50° field of view
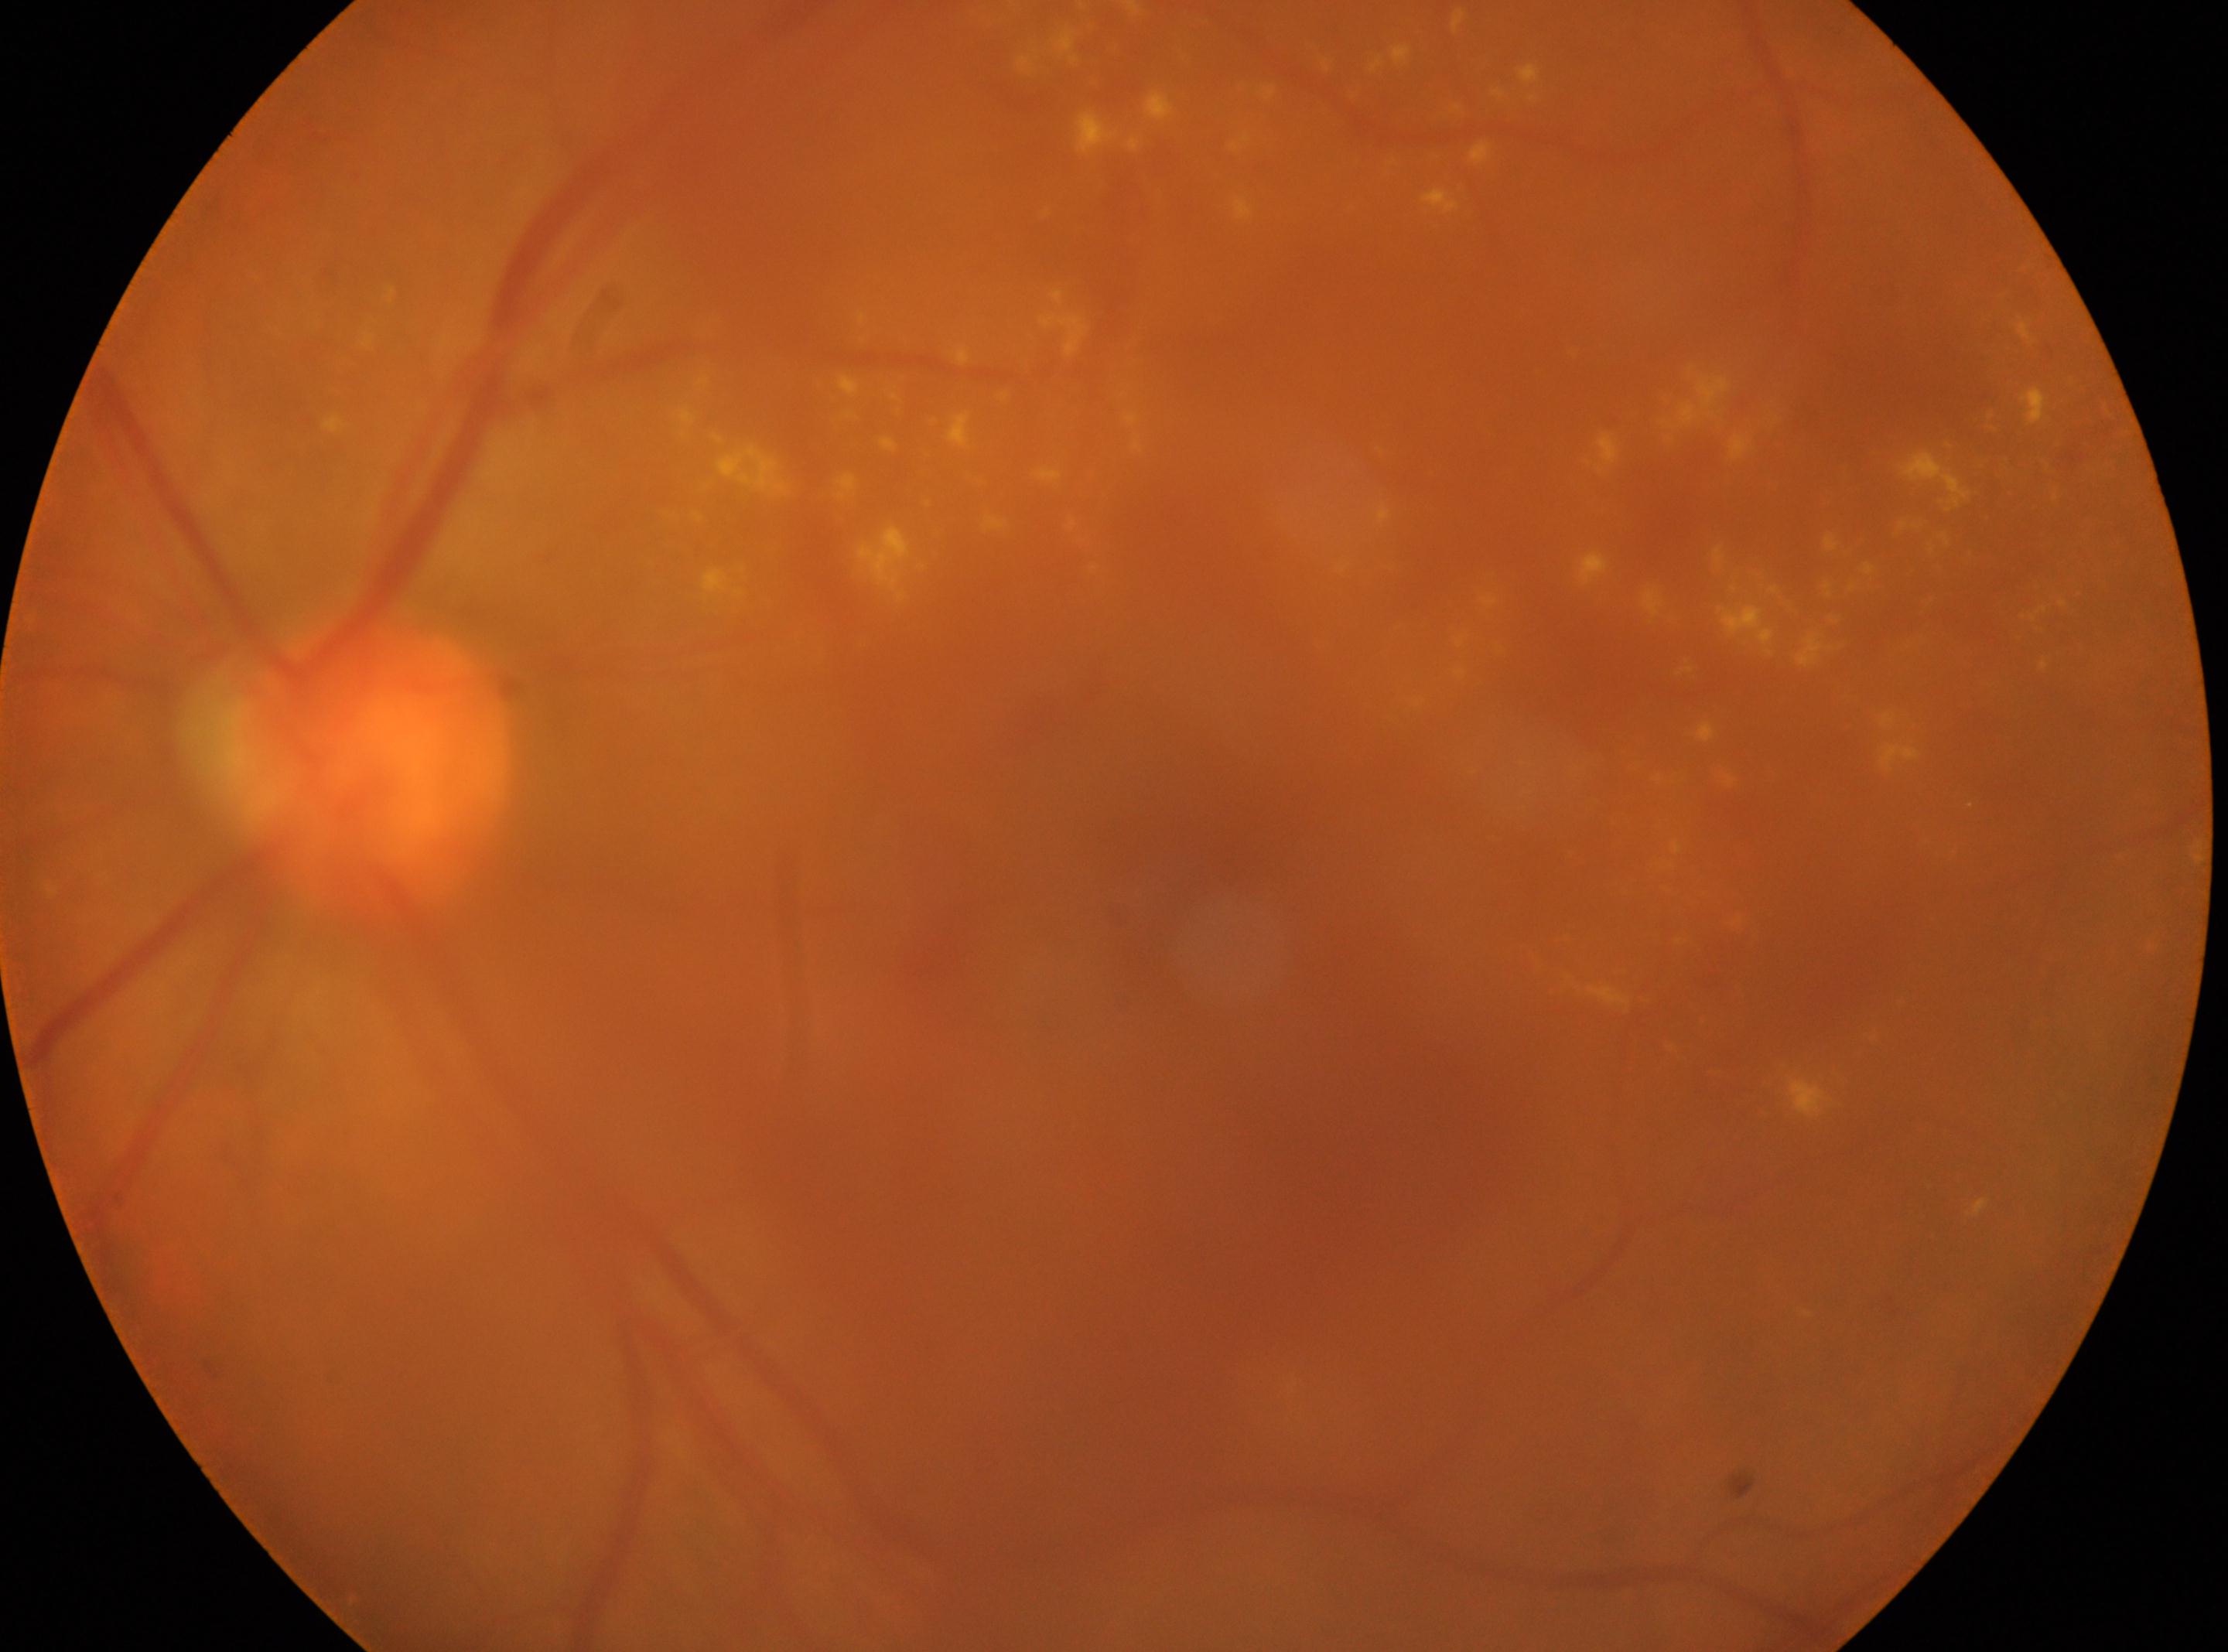

Annotations:
– diabetic retinopathy (DR) — moderate NPDR (grade 2)
– ONH — (x=368, y=767)
– laterality — left
– foveal center — (x=1208, y=886)